45° FOV. Image size 1932x1916
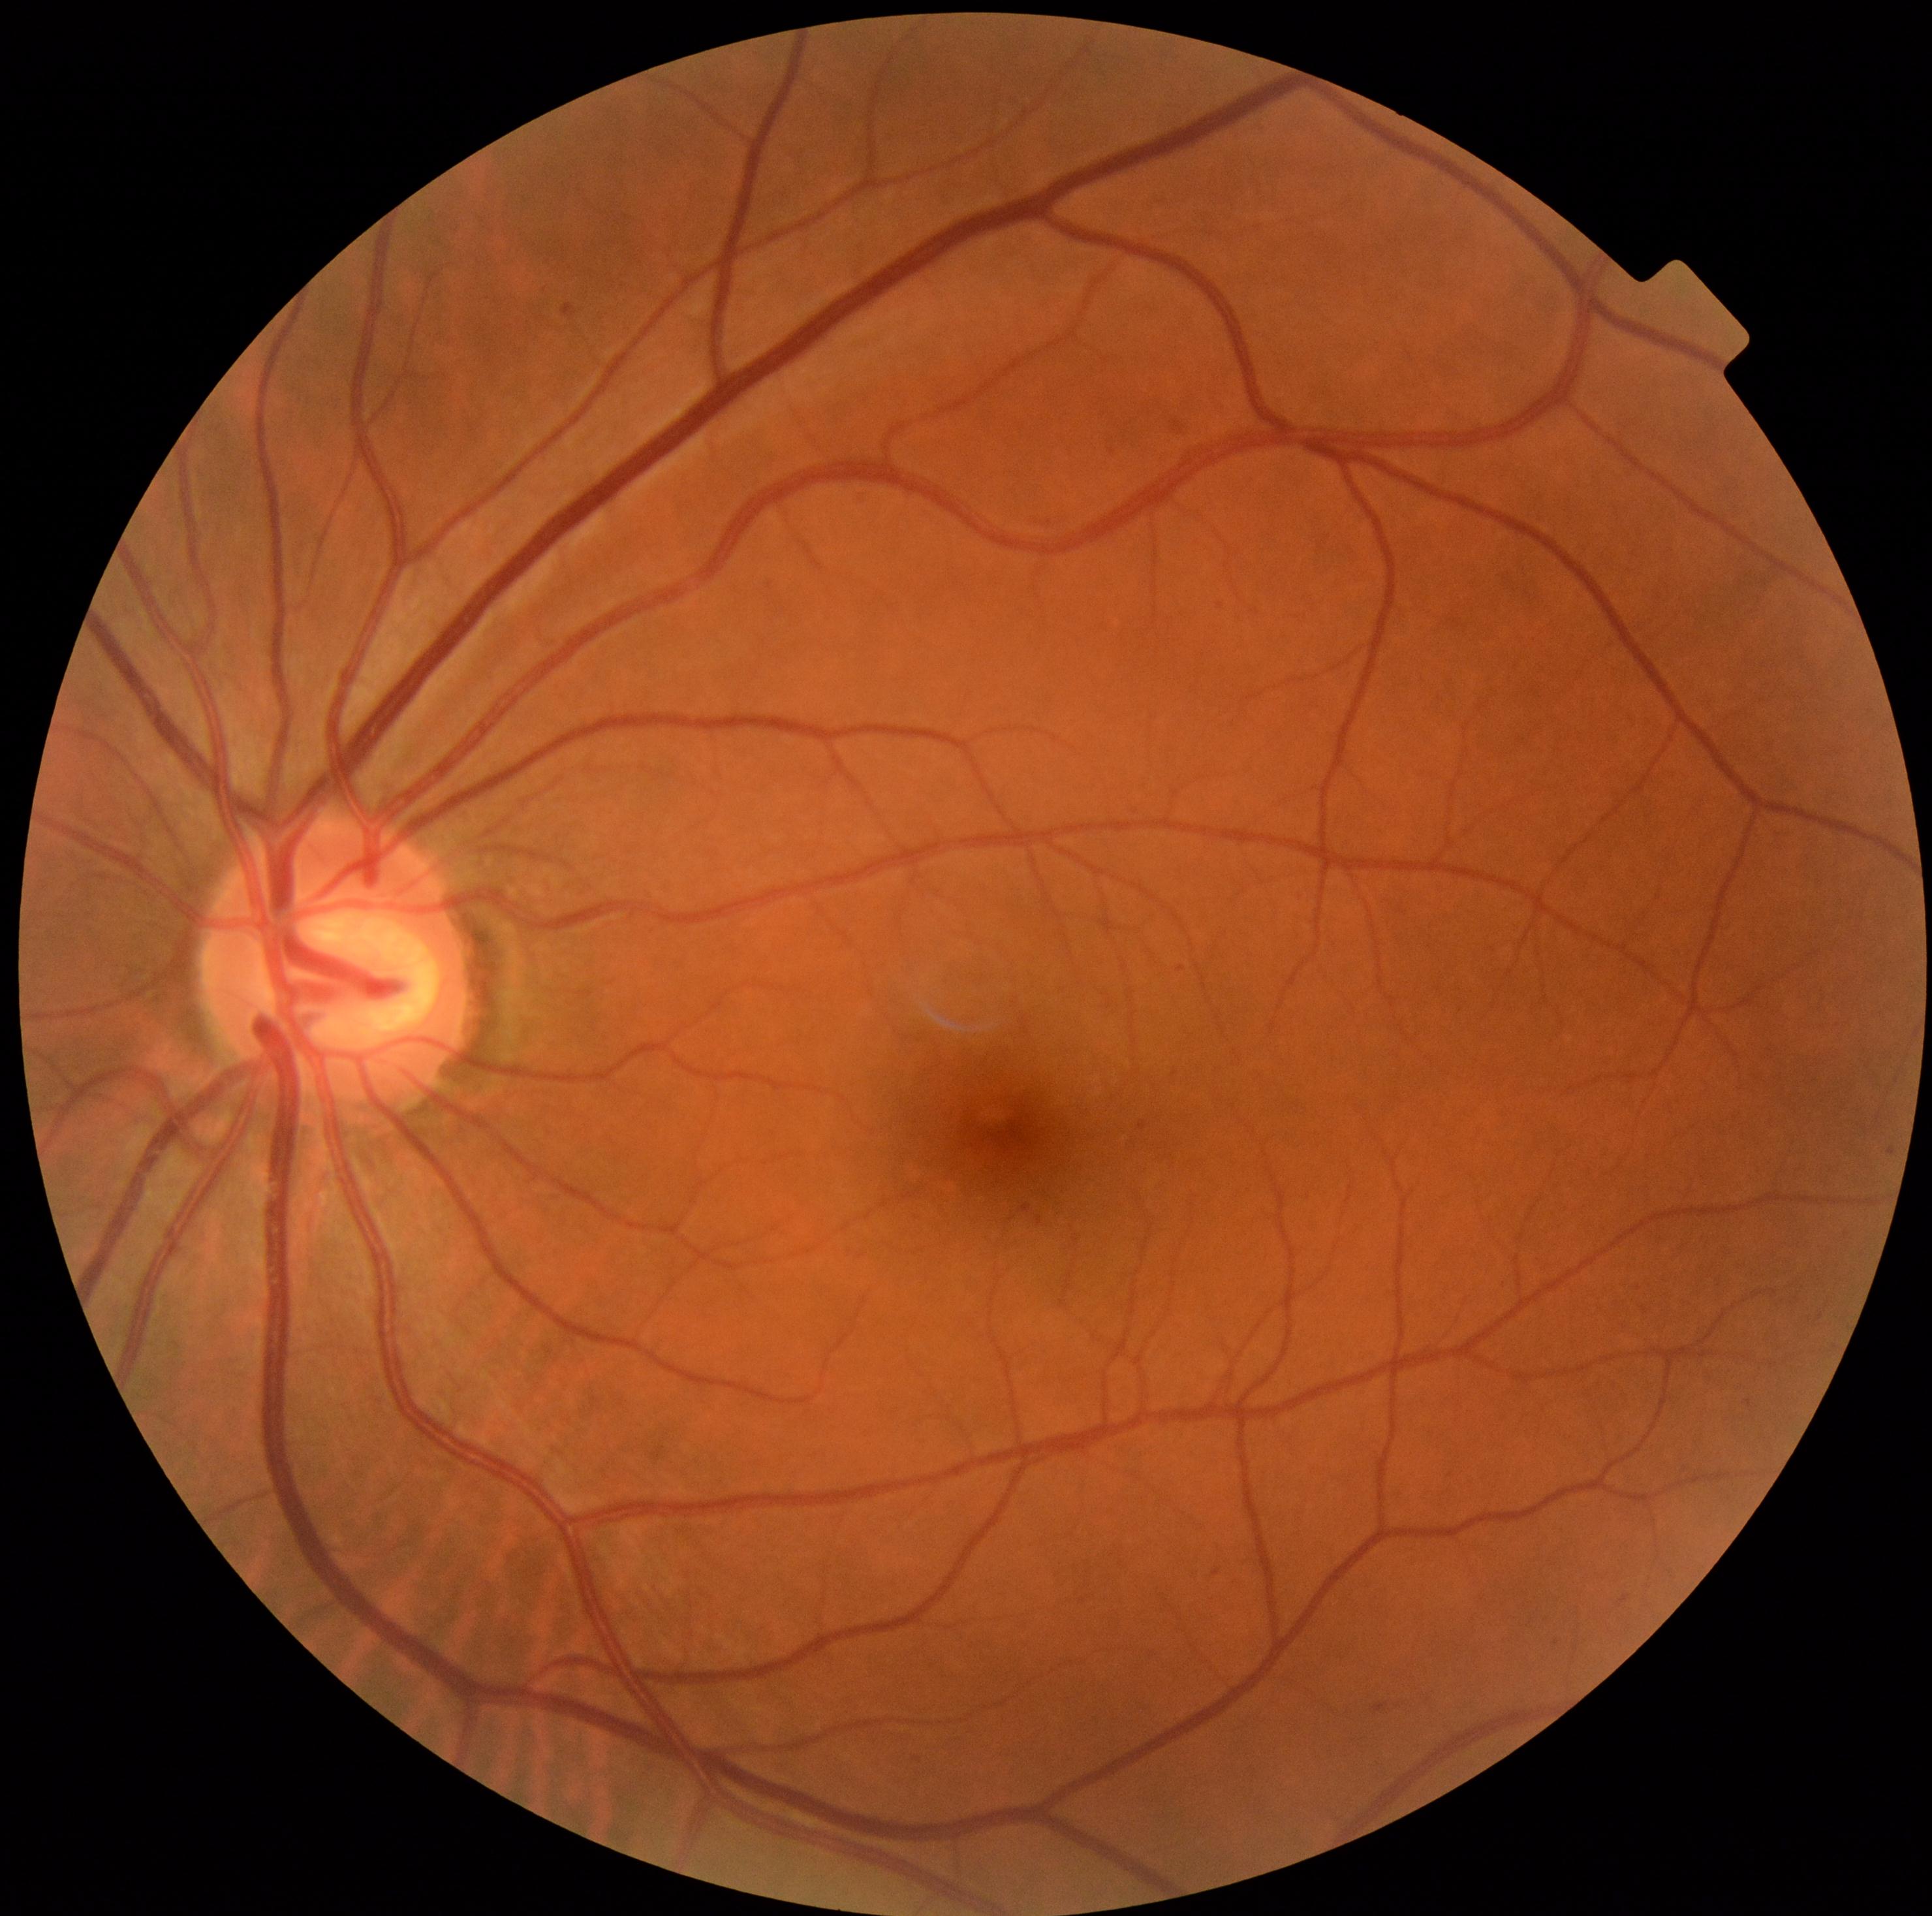 Diabetic retinopathy: mild NPDR (grade 1).